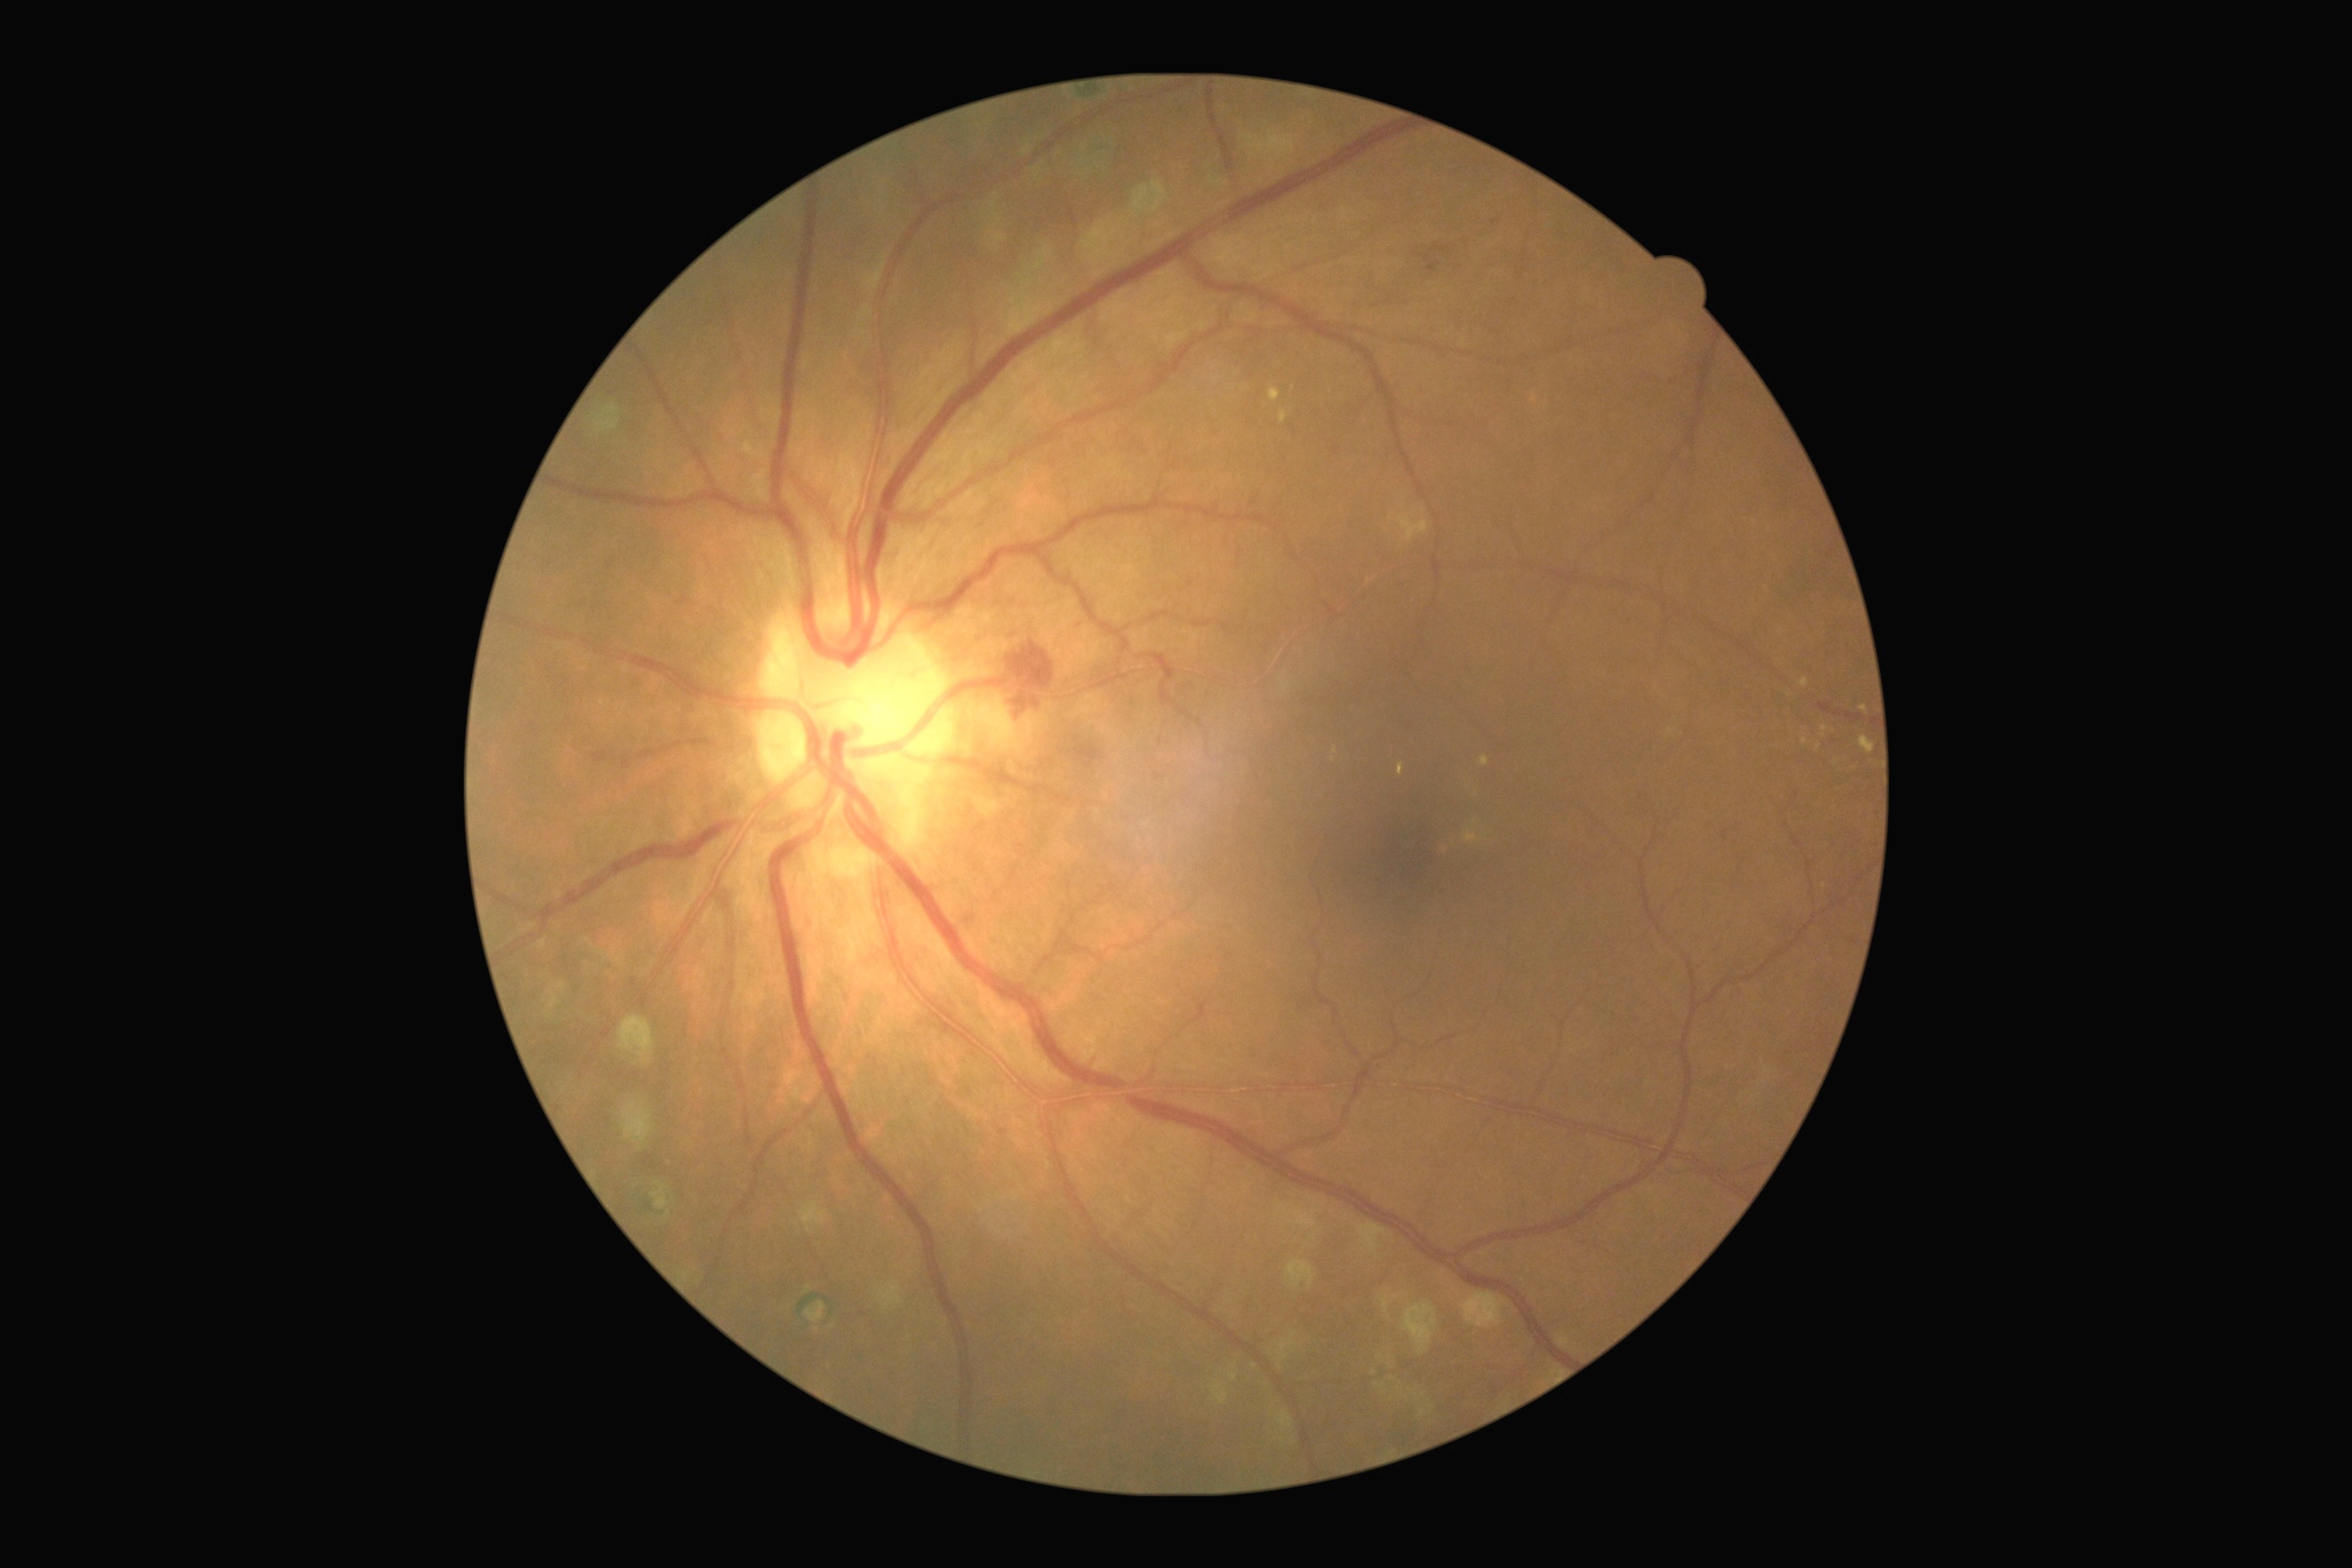

<lesions partial="true">
  <dr_grade>2</dr_grade>
  <ex partial="true">region(1464, 830, 1482, 843) | region(1280, 411, 1288, 424) | region(1398, 763, 1404, 776) | region(1480, 756, 1489, 767) | region(1859, 736, 1874, 754) | region(1799, 678, 1808, 687) | region(1859, 705, 1868, 714) | region(1269, 387, 1282, 402) | region(1398, 516, 1429, 544)</ex>
  <ex_small_approx>1824:728 | 1805:741 | 1819:748 | 1536:400</ex_small_approx>
  <ma>region(1427, 262, 1440, 275)</ma>
  <he>region(997, 642, 1055, 723)</he>
  <se />
</lesions>